Pediatric retinal photograph (wide-field):
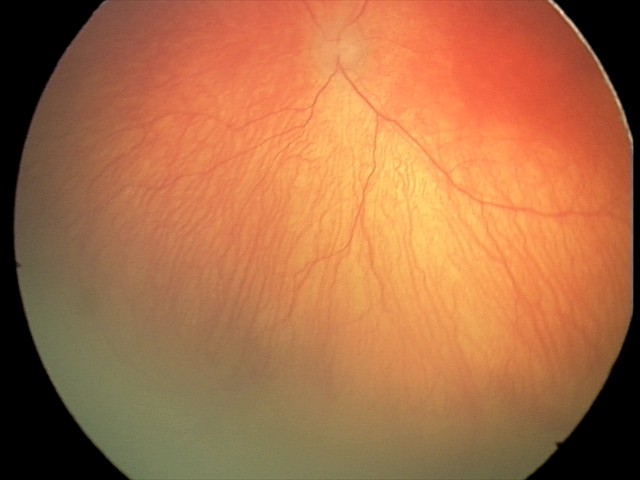
With plus disease. Diagnosis from this screening exam: aggressive retinopathy of prematurity — rapidly progressive severe ROP with prominent plus disease, often without classic stage progression.